2212x1659.
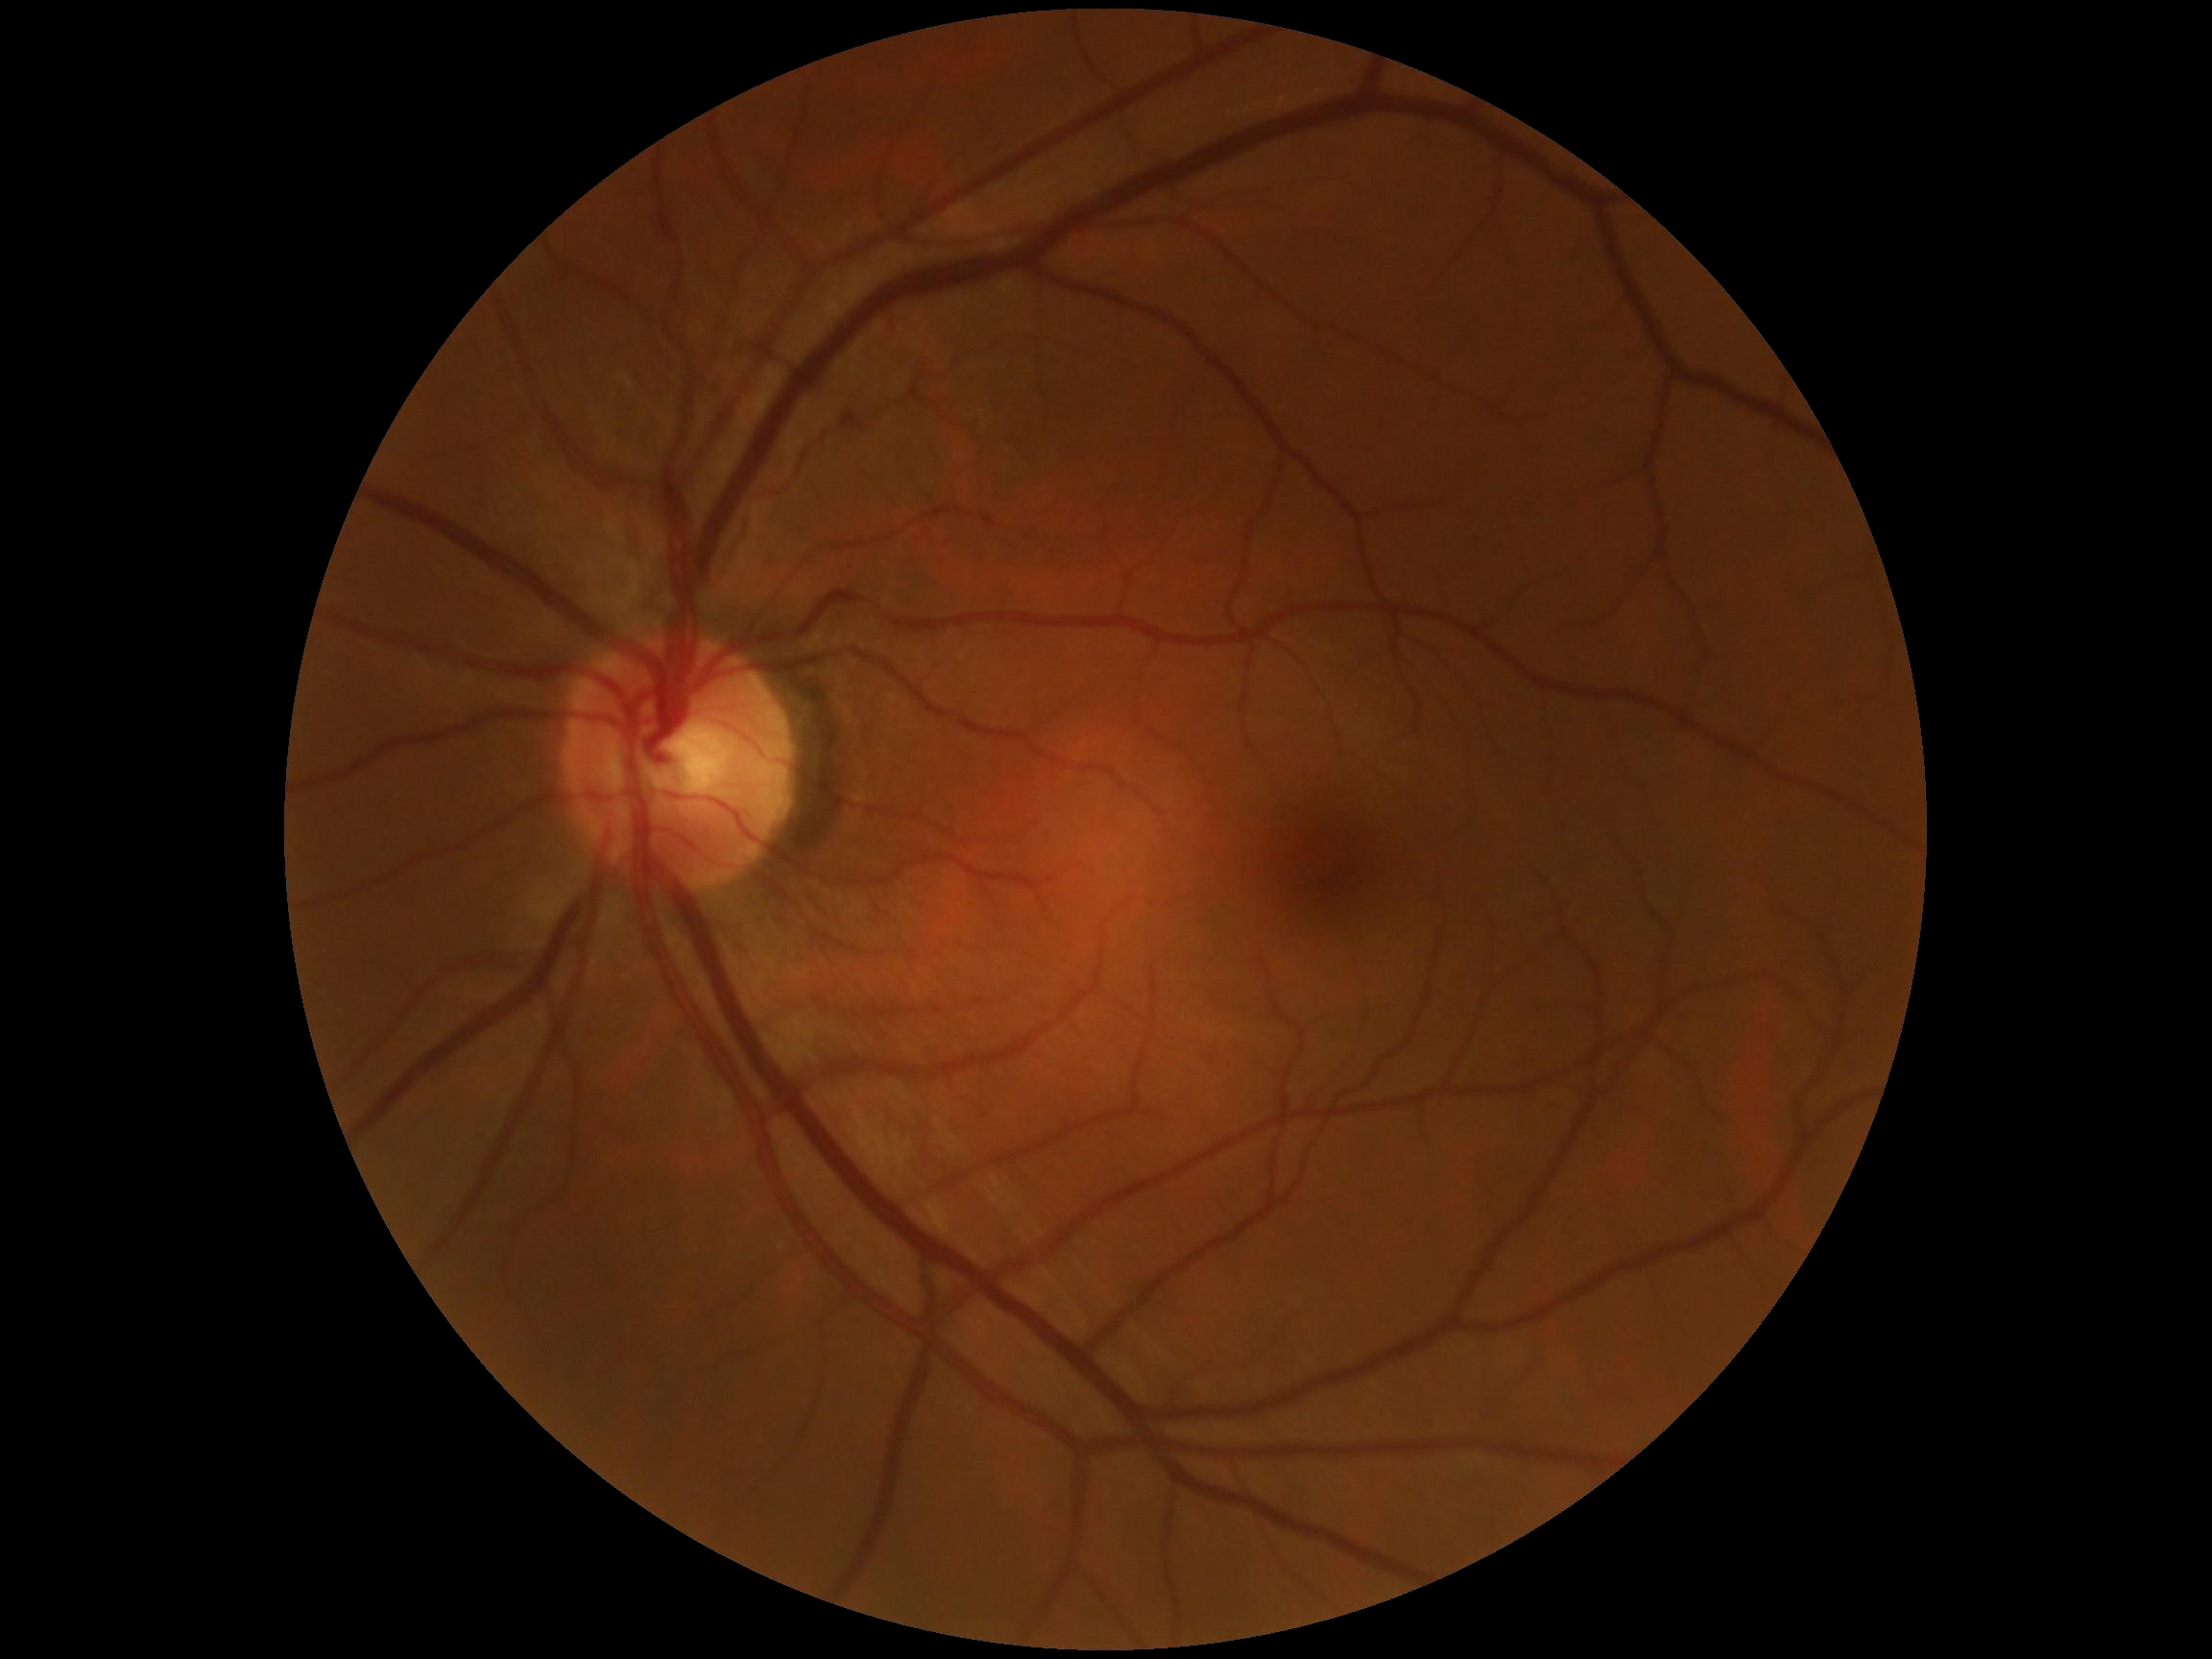 DR stage: 0/4.